Image size 640x480 · infant wide-field fundus photograph · camera: Clarity RetCam 3 (130° FOV)
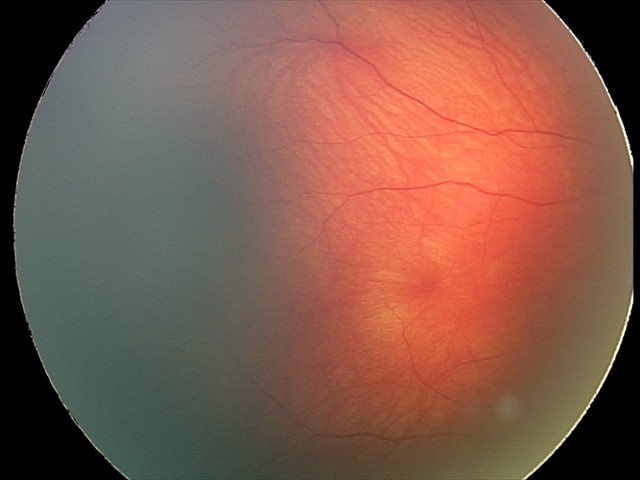 Examination diagnosed as retinal hemorrhages.